CFP — 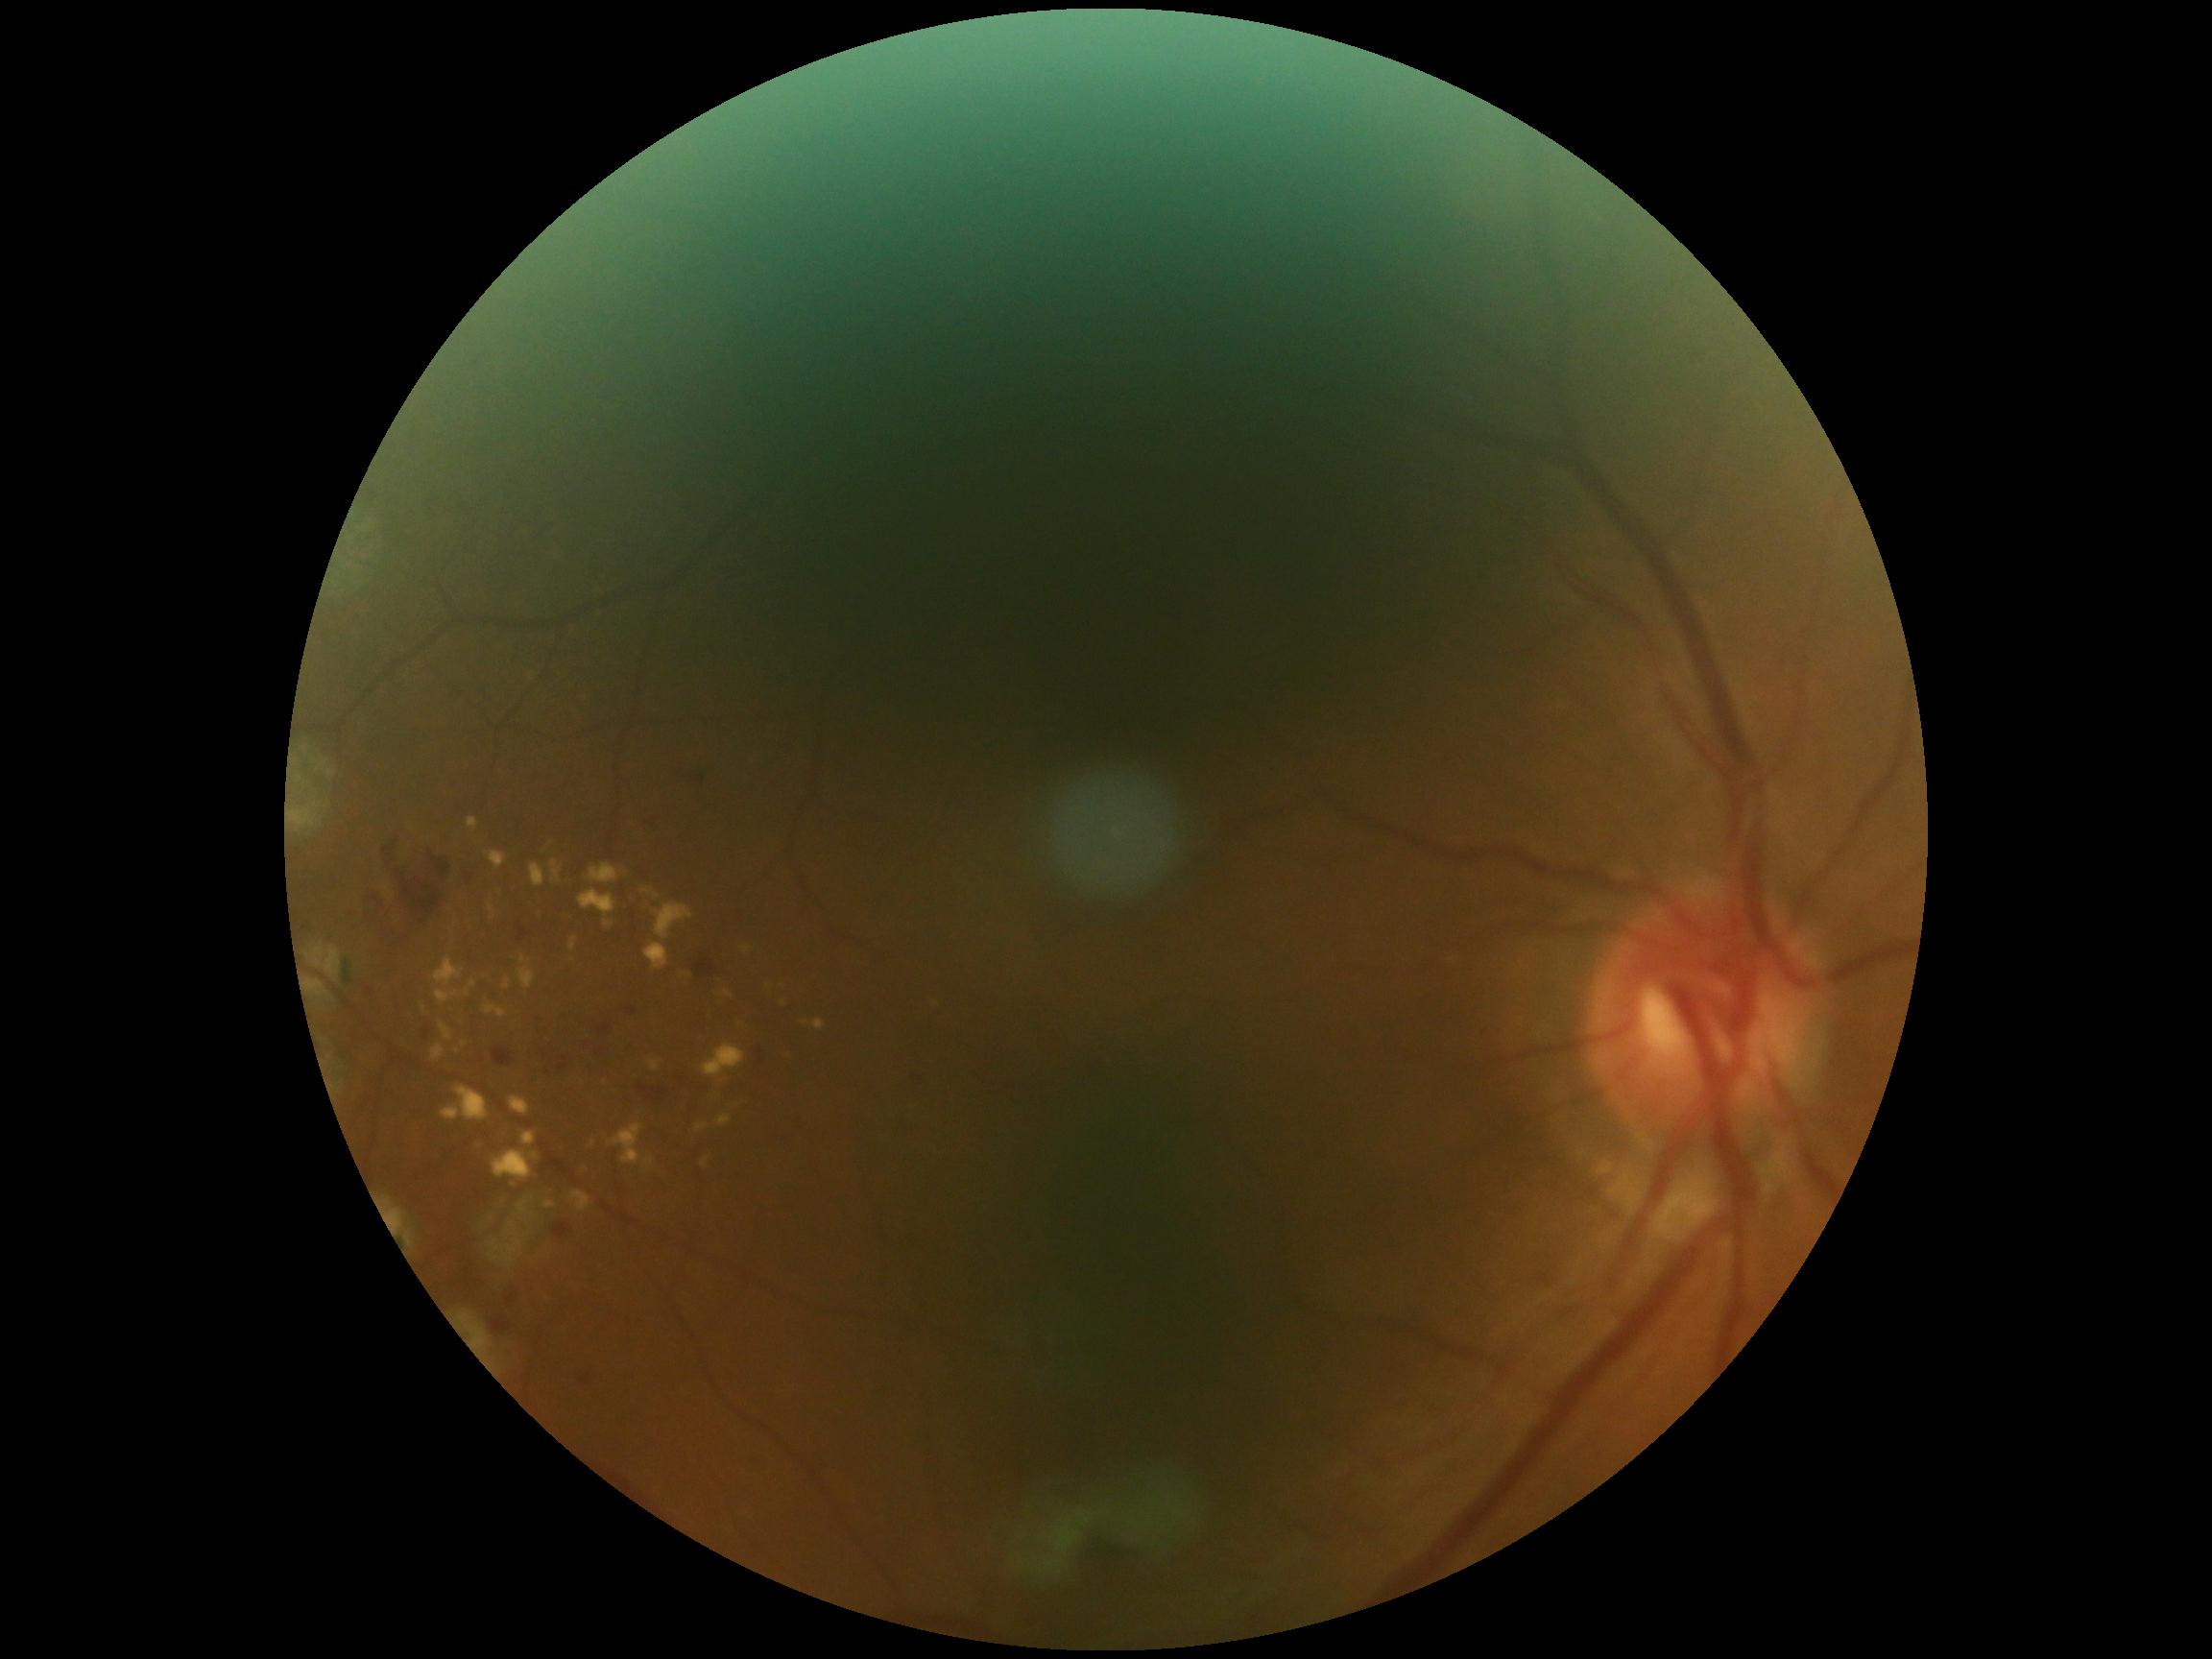

  dr_grade: grade 2